Infant wide-field fundus photograph · 1440x1080: 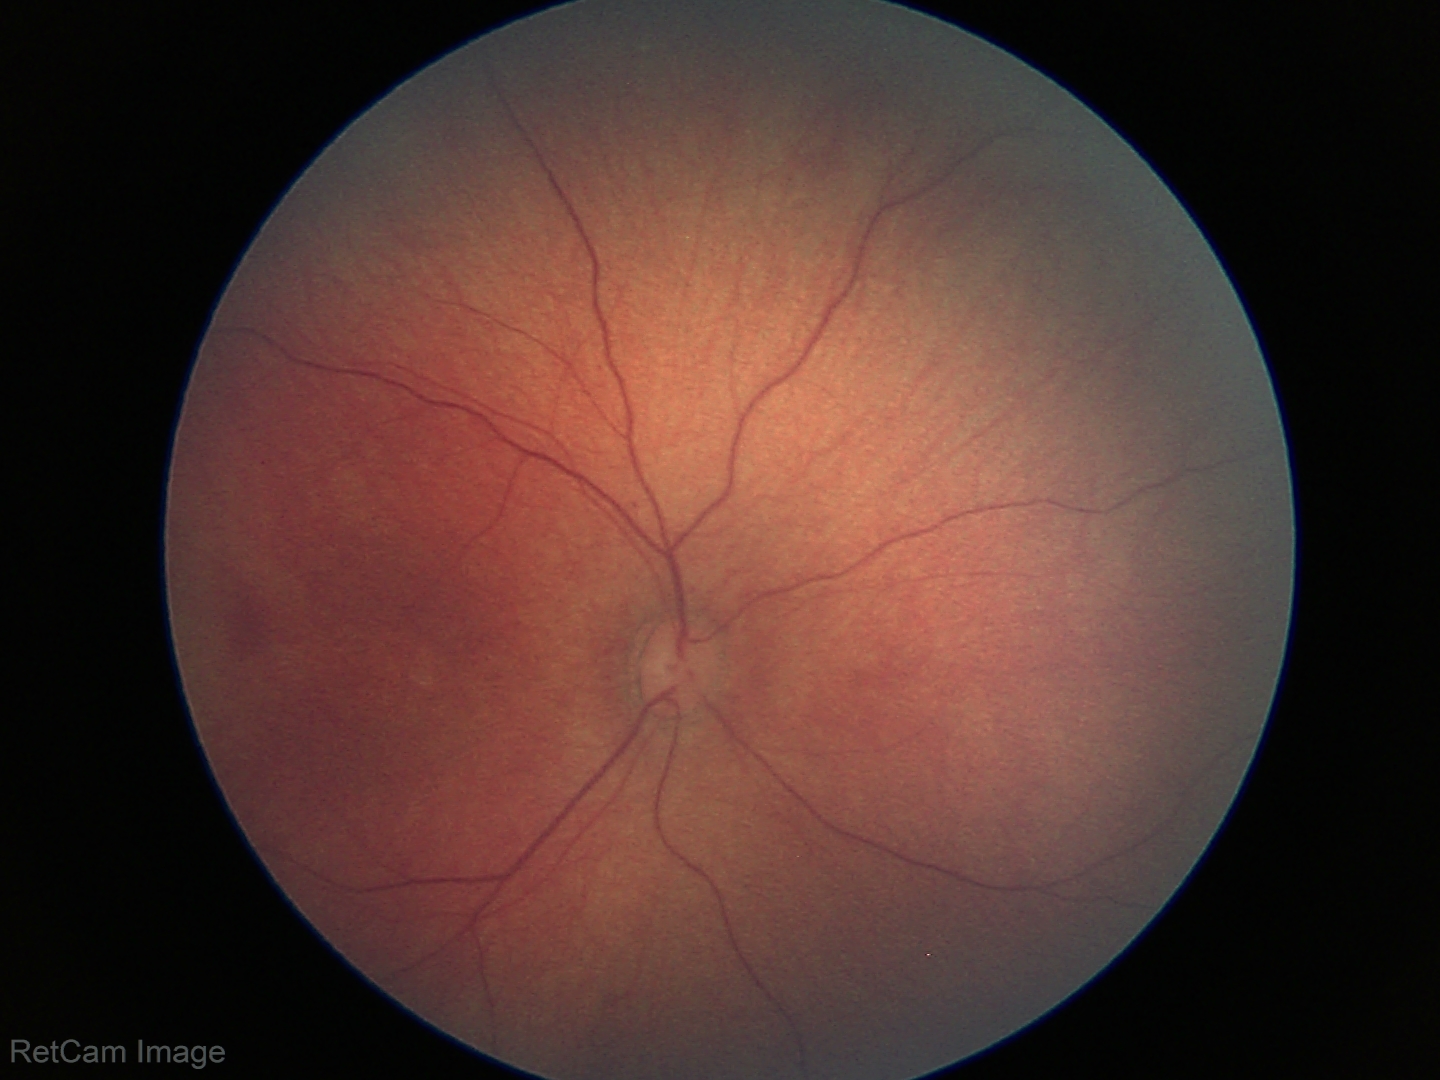

Examination with physiological retinal findings.